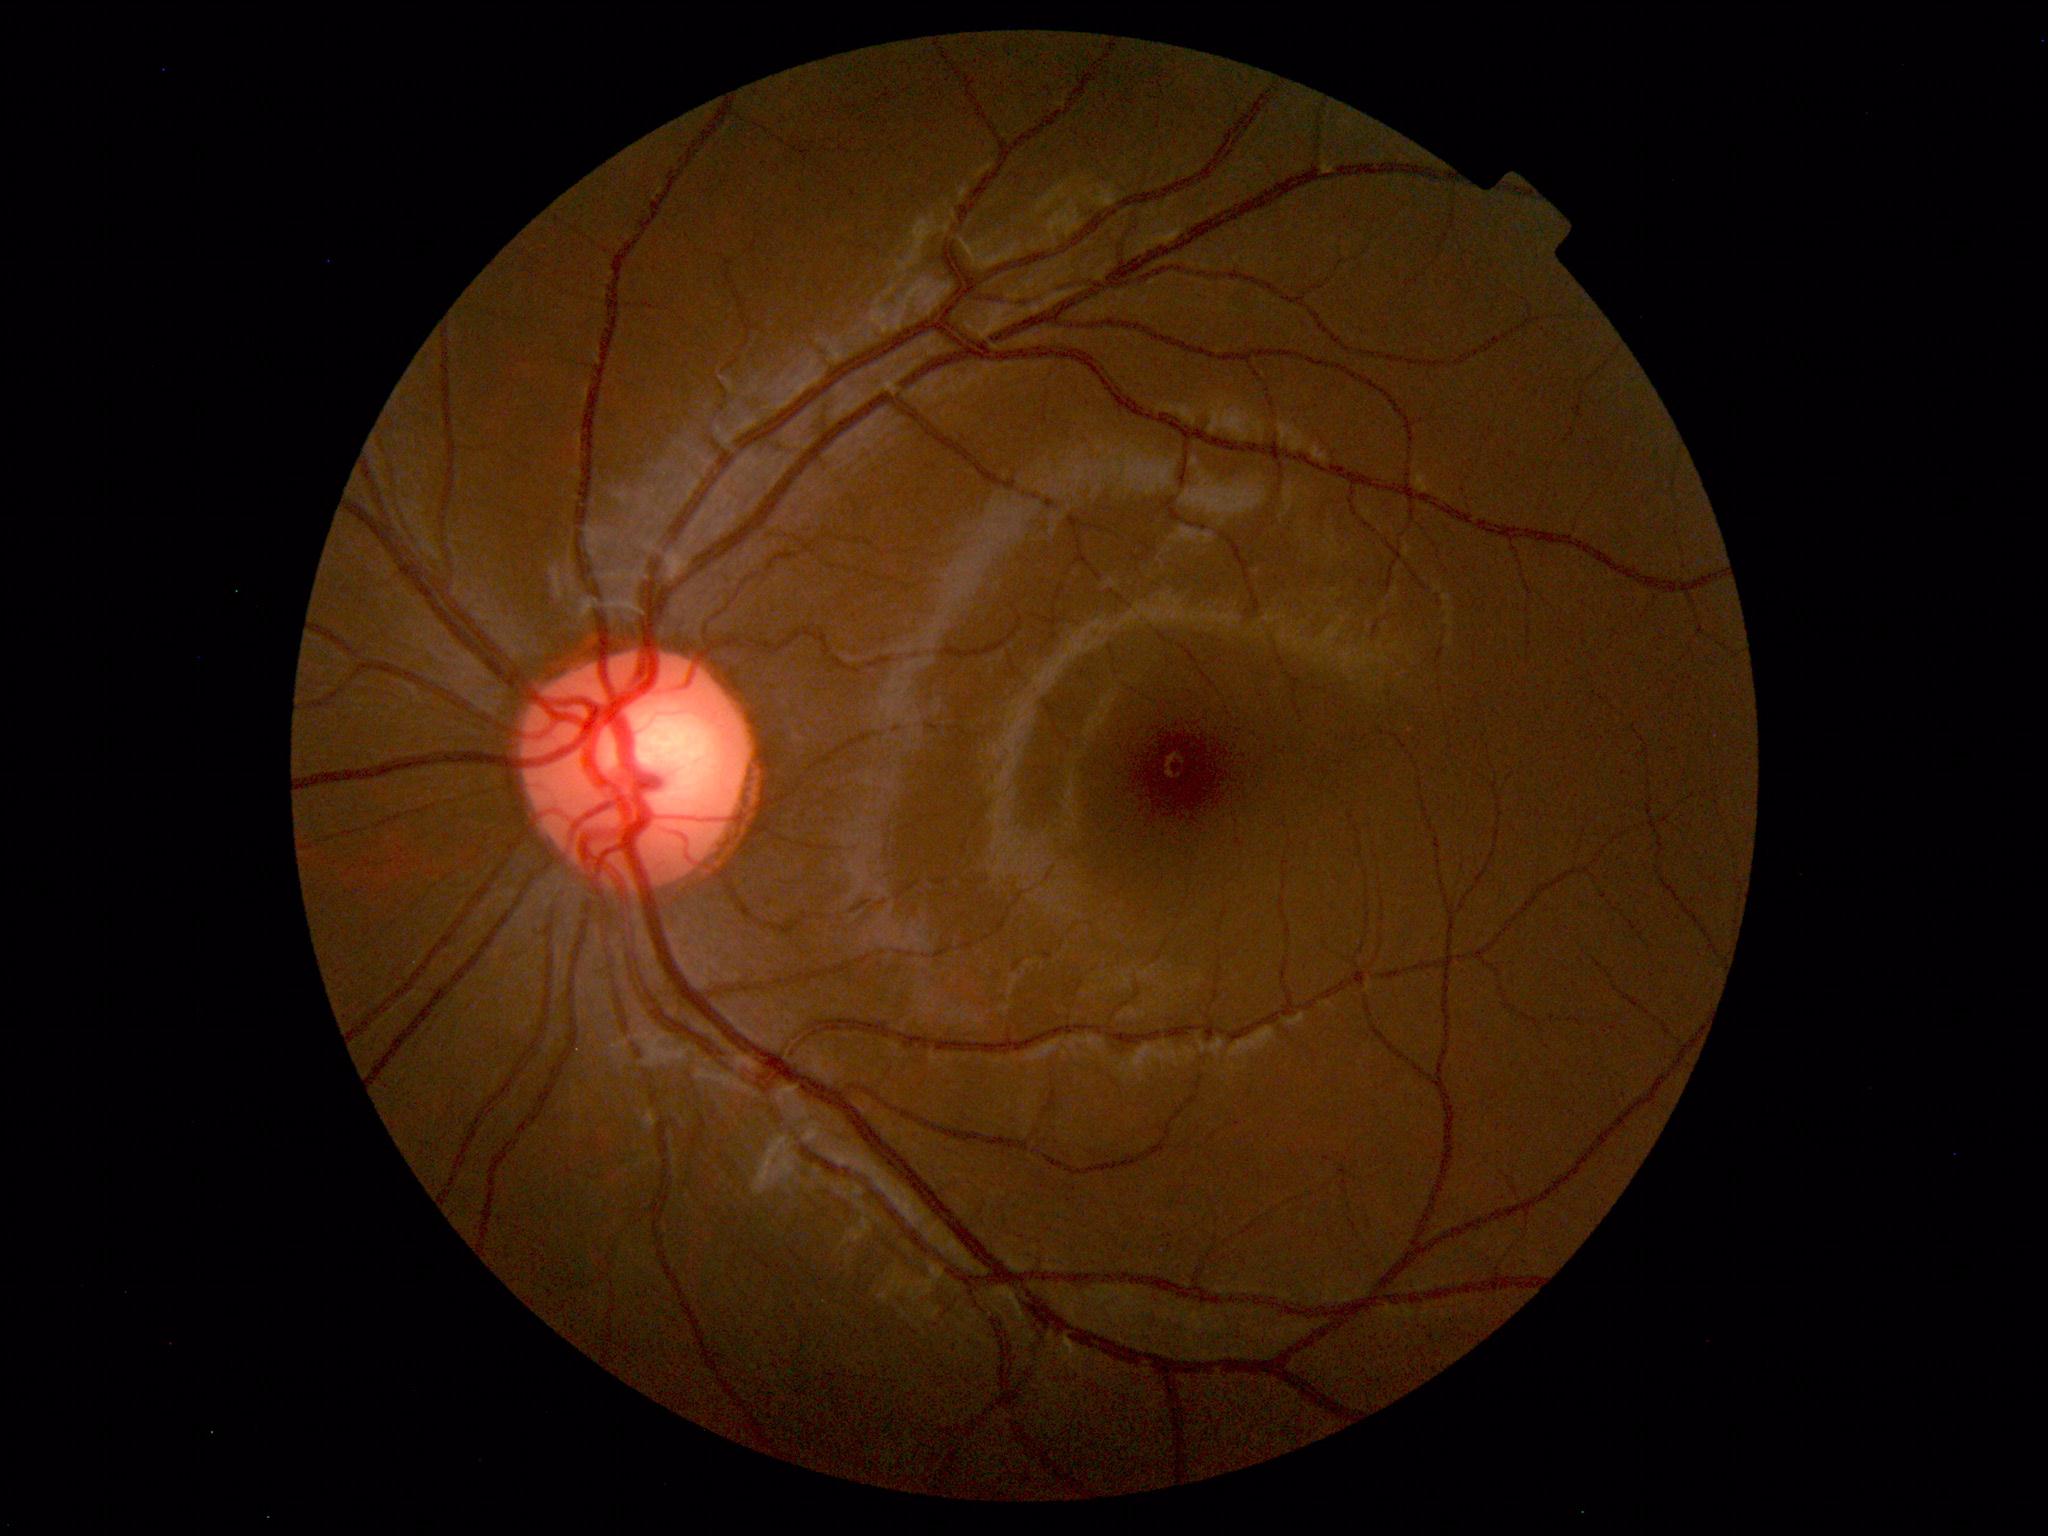
Normal fundus appearance.